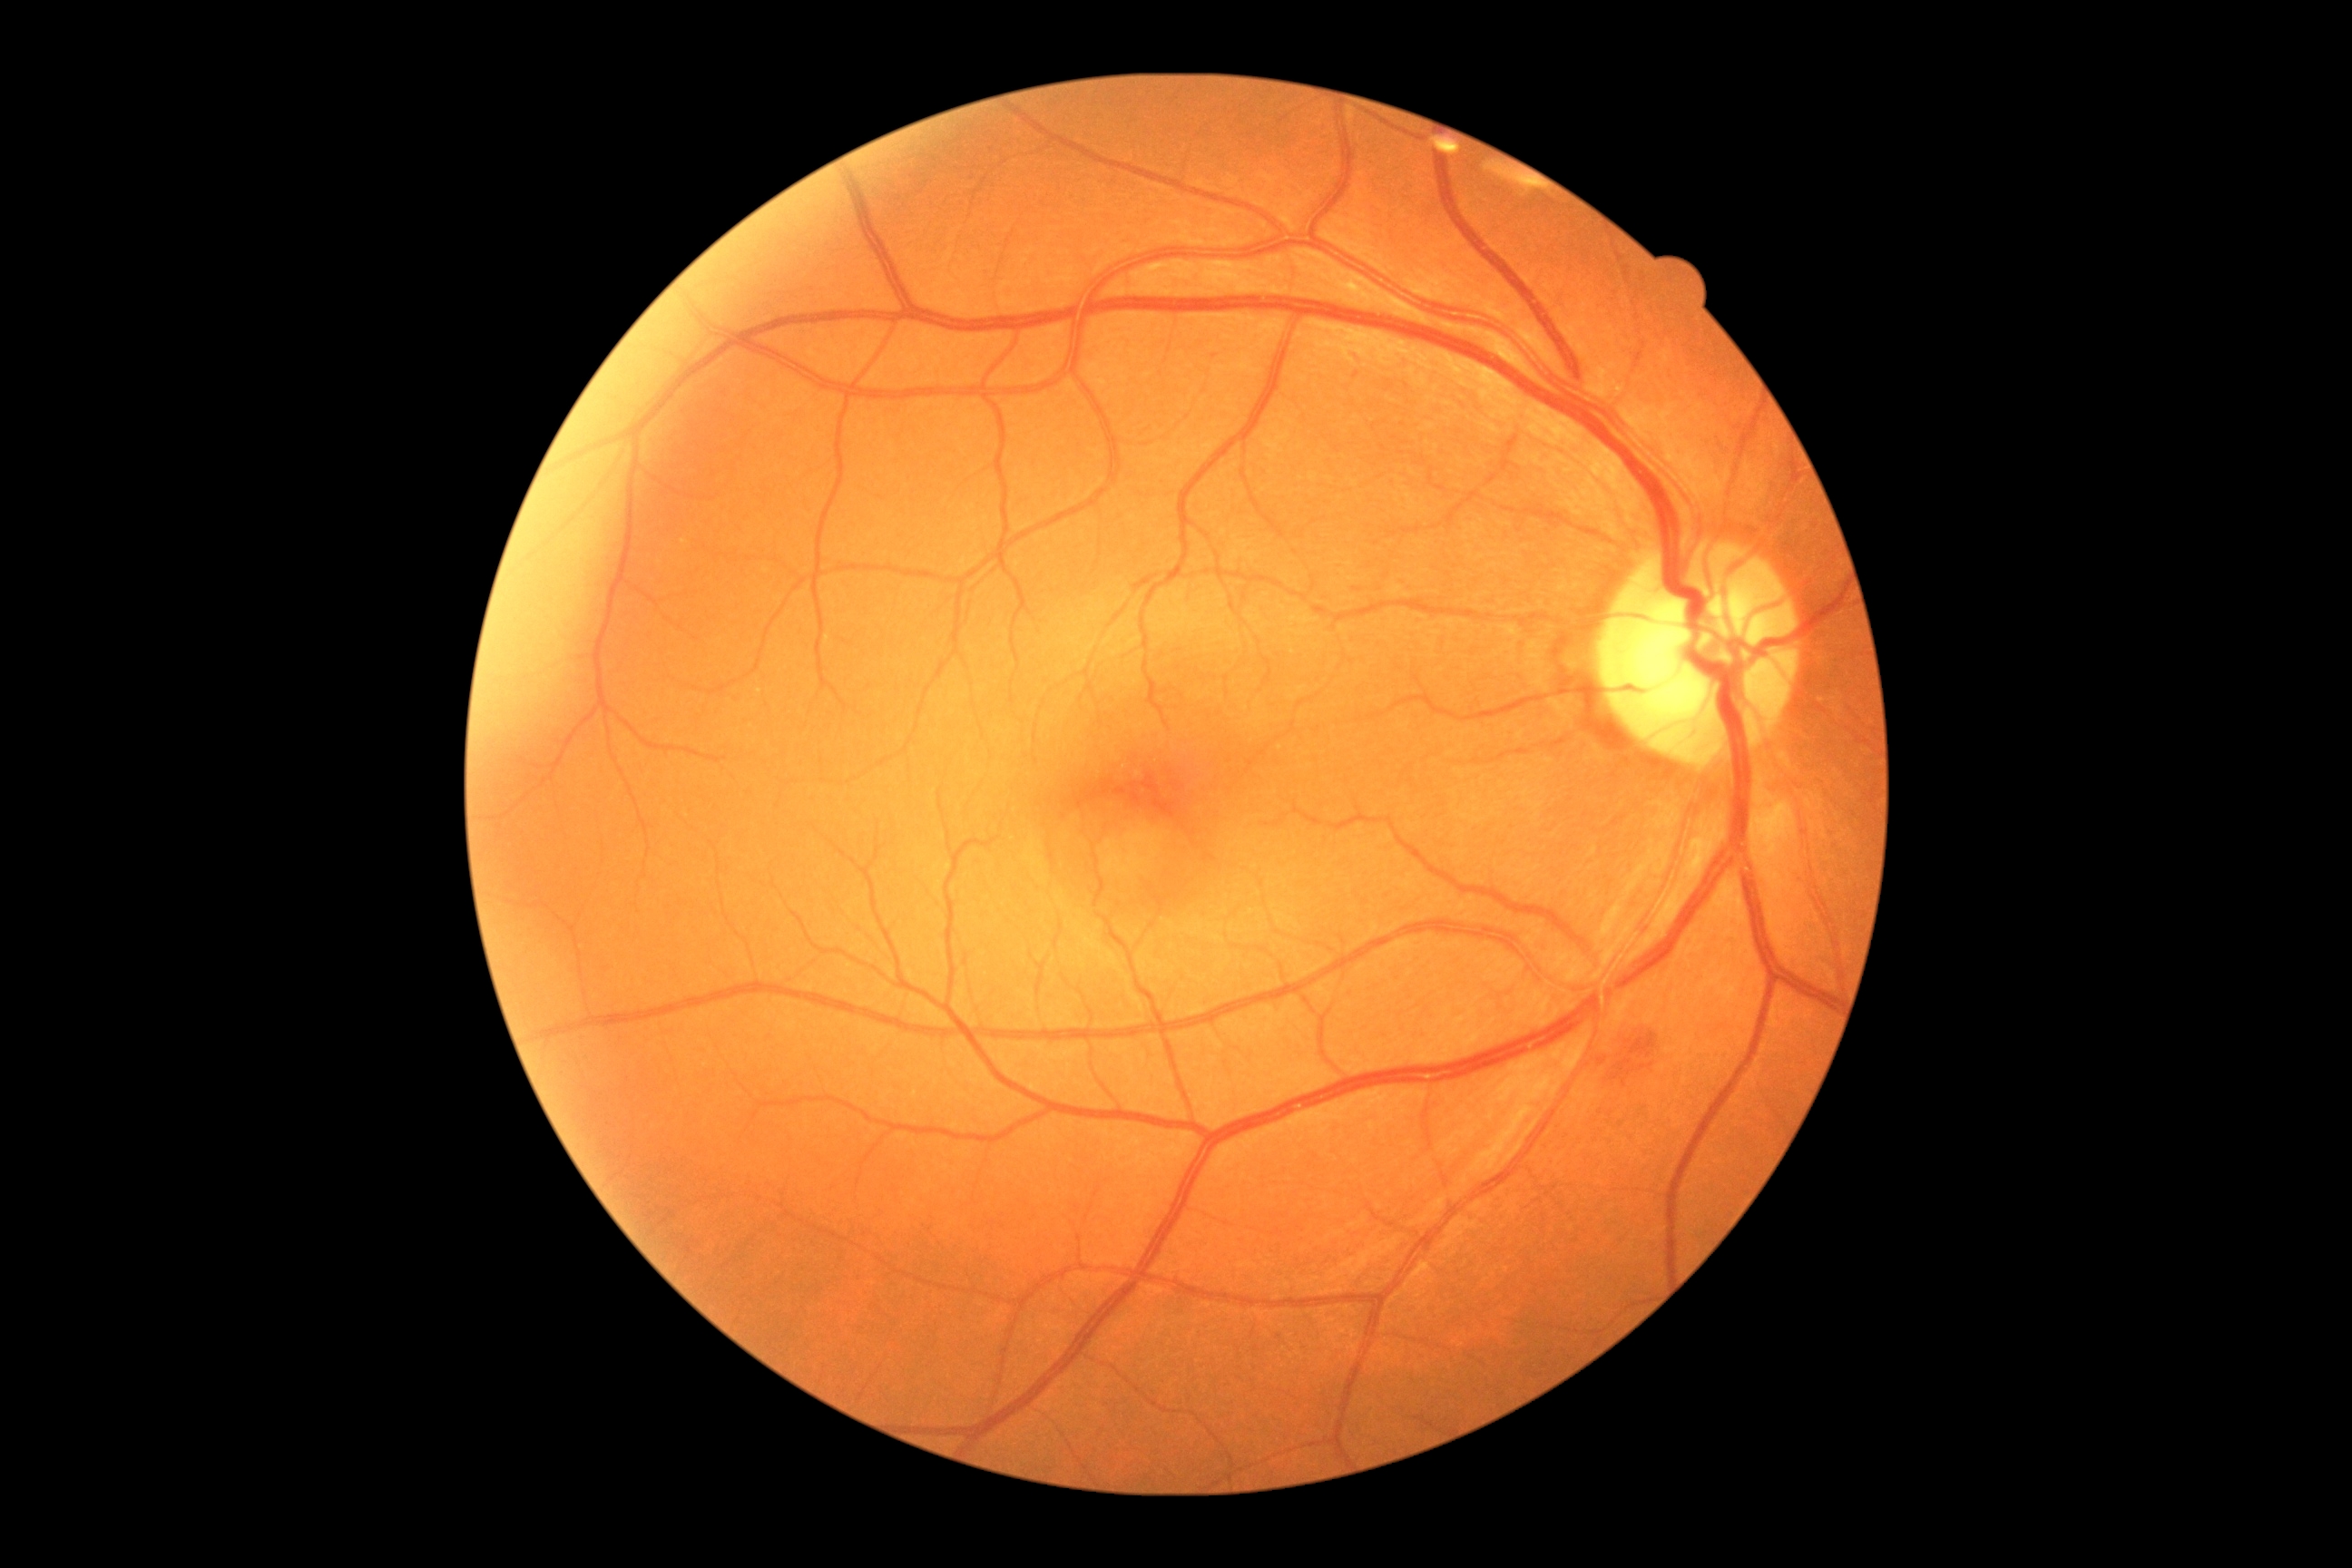

Diabetic retinopathy (DR) is grade 2 (moderate NPDR).